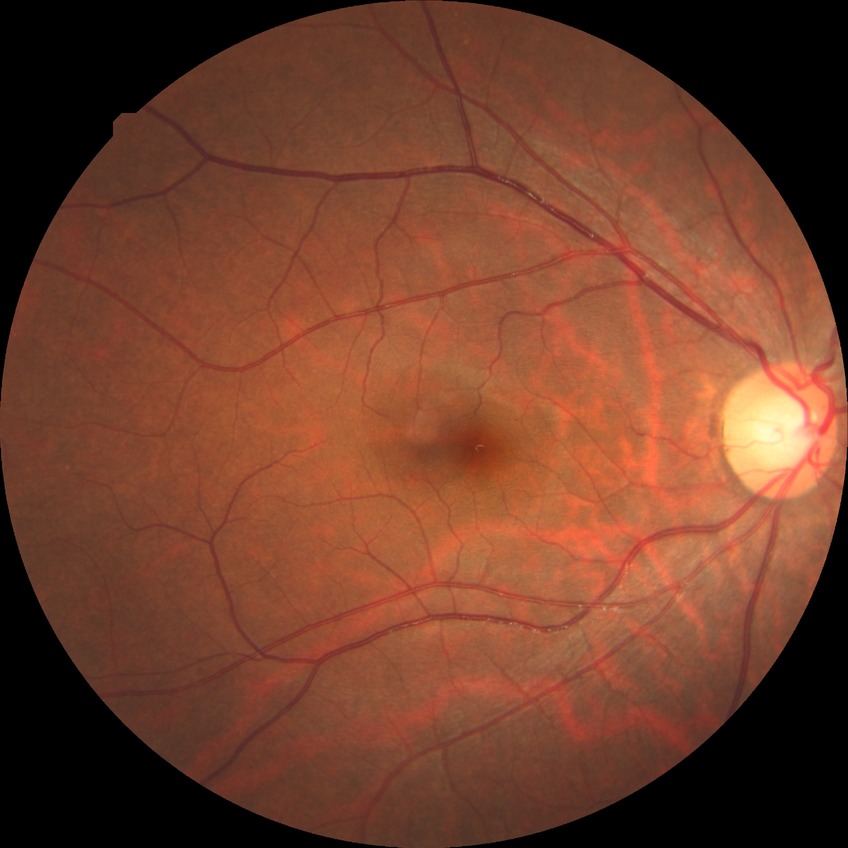

Assessment:
– diabetic retinopathy (DR): NDR (no diabetic retinopathy)